CFP; 848 x 848 pixels: 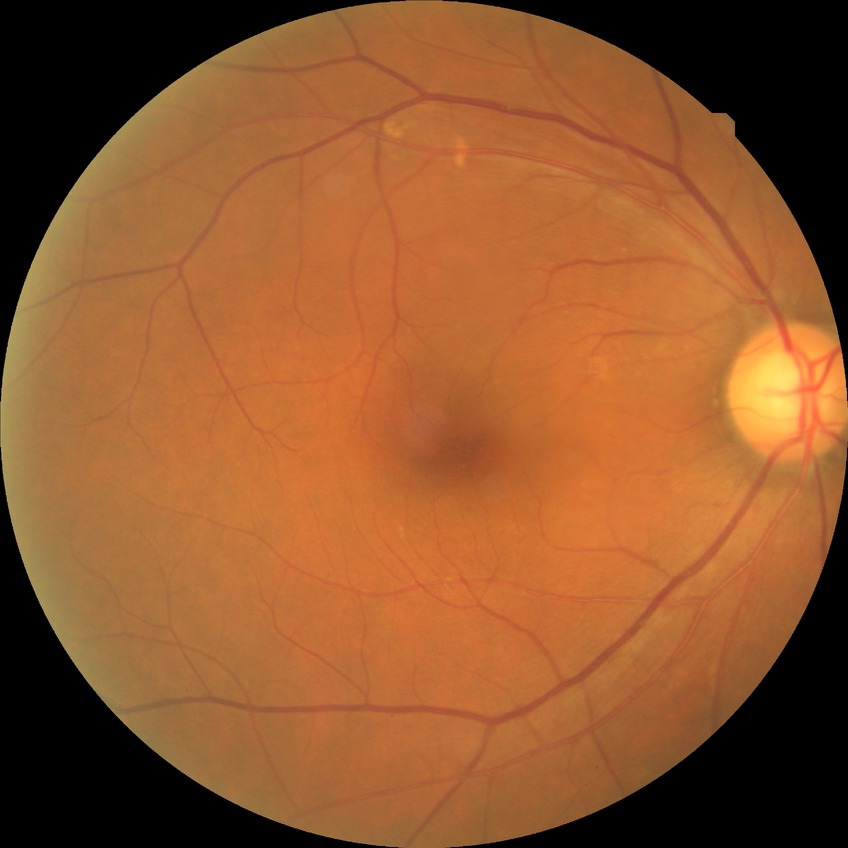

Davis stage is NDR.